60° field of view, color fundus photograph from a handheld portable camera: 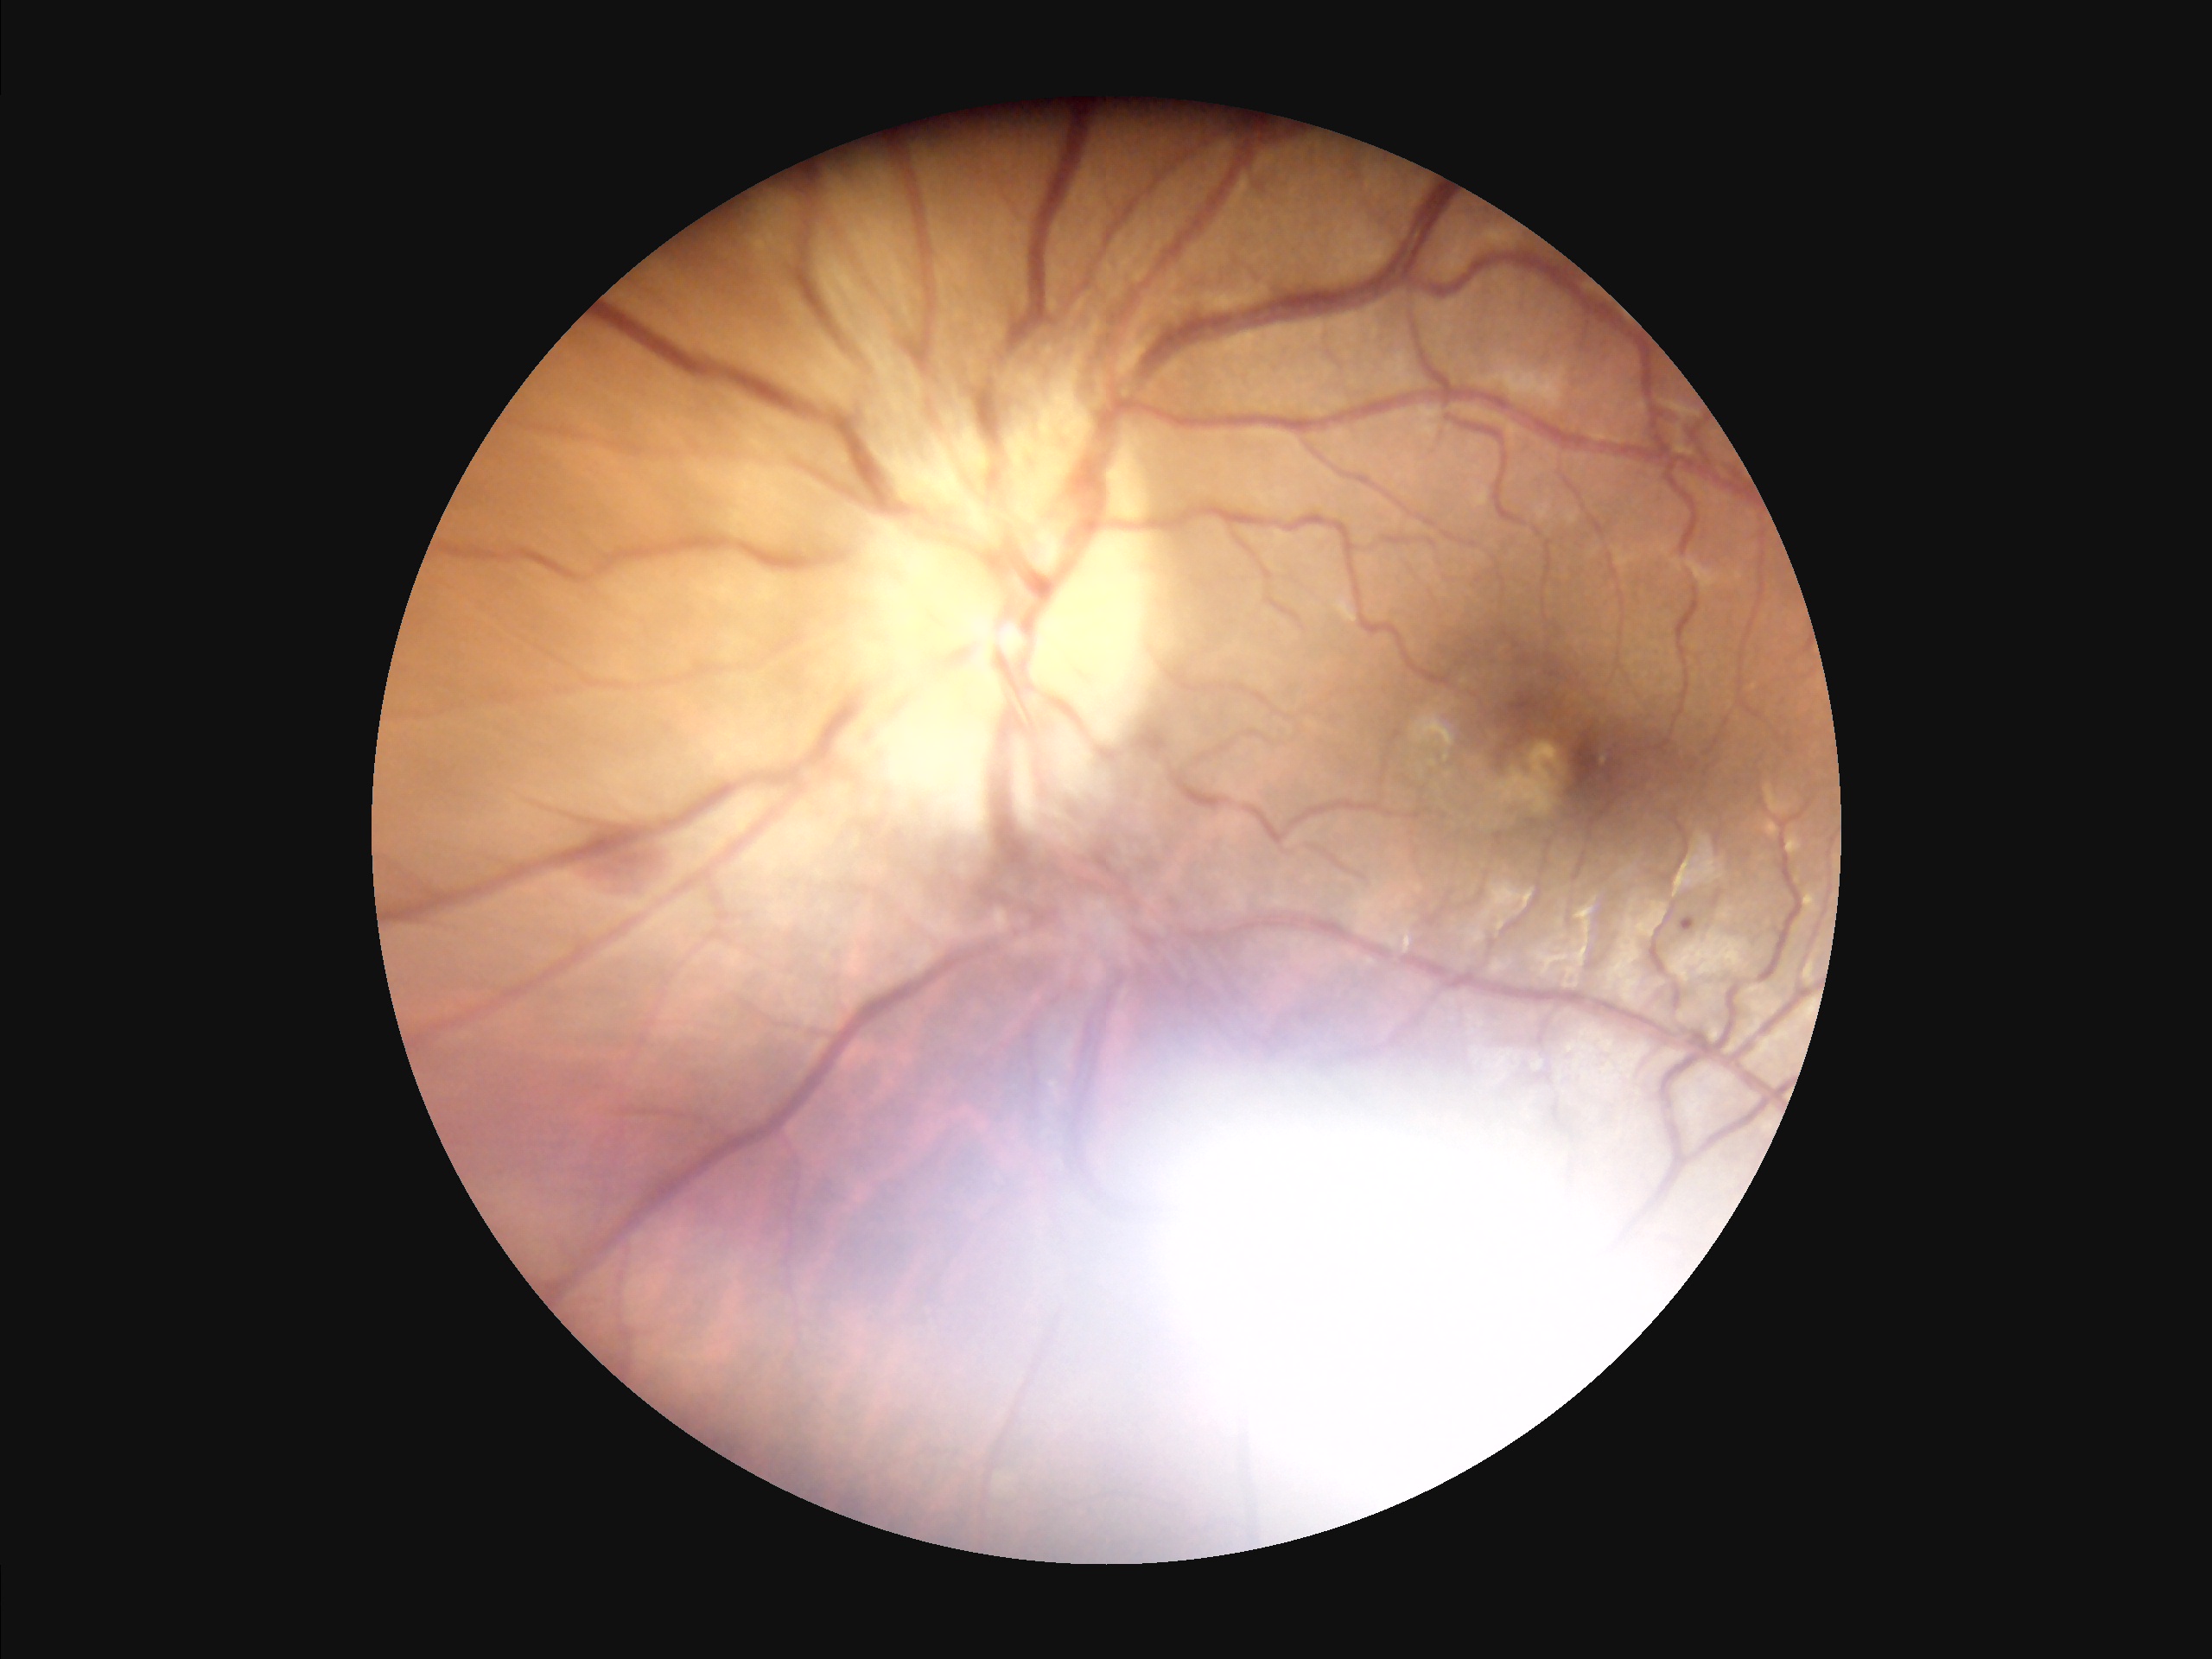
The image is blurry.
Illumination is uneven.
Overall image quality is poor.